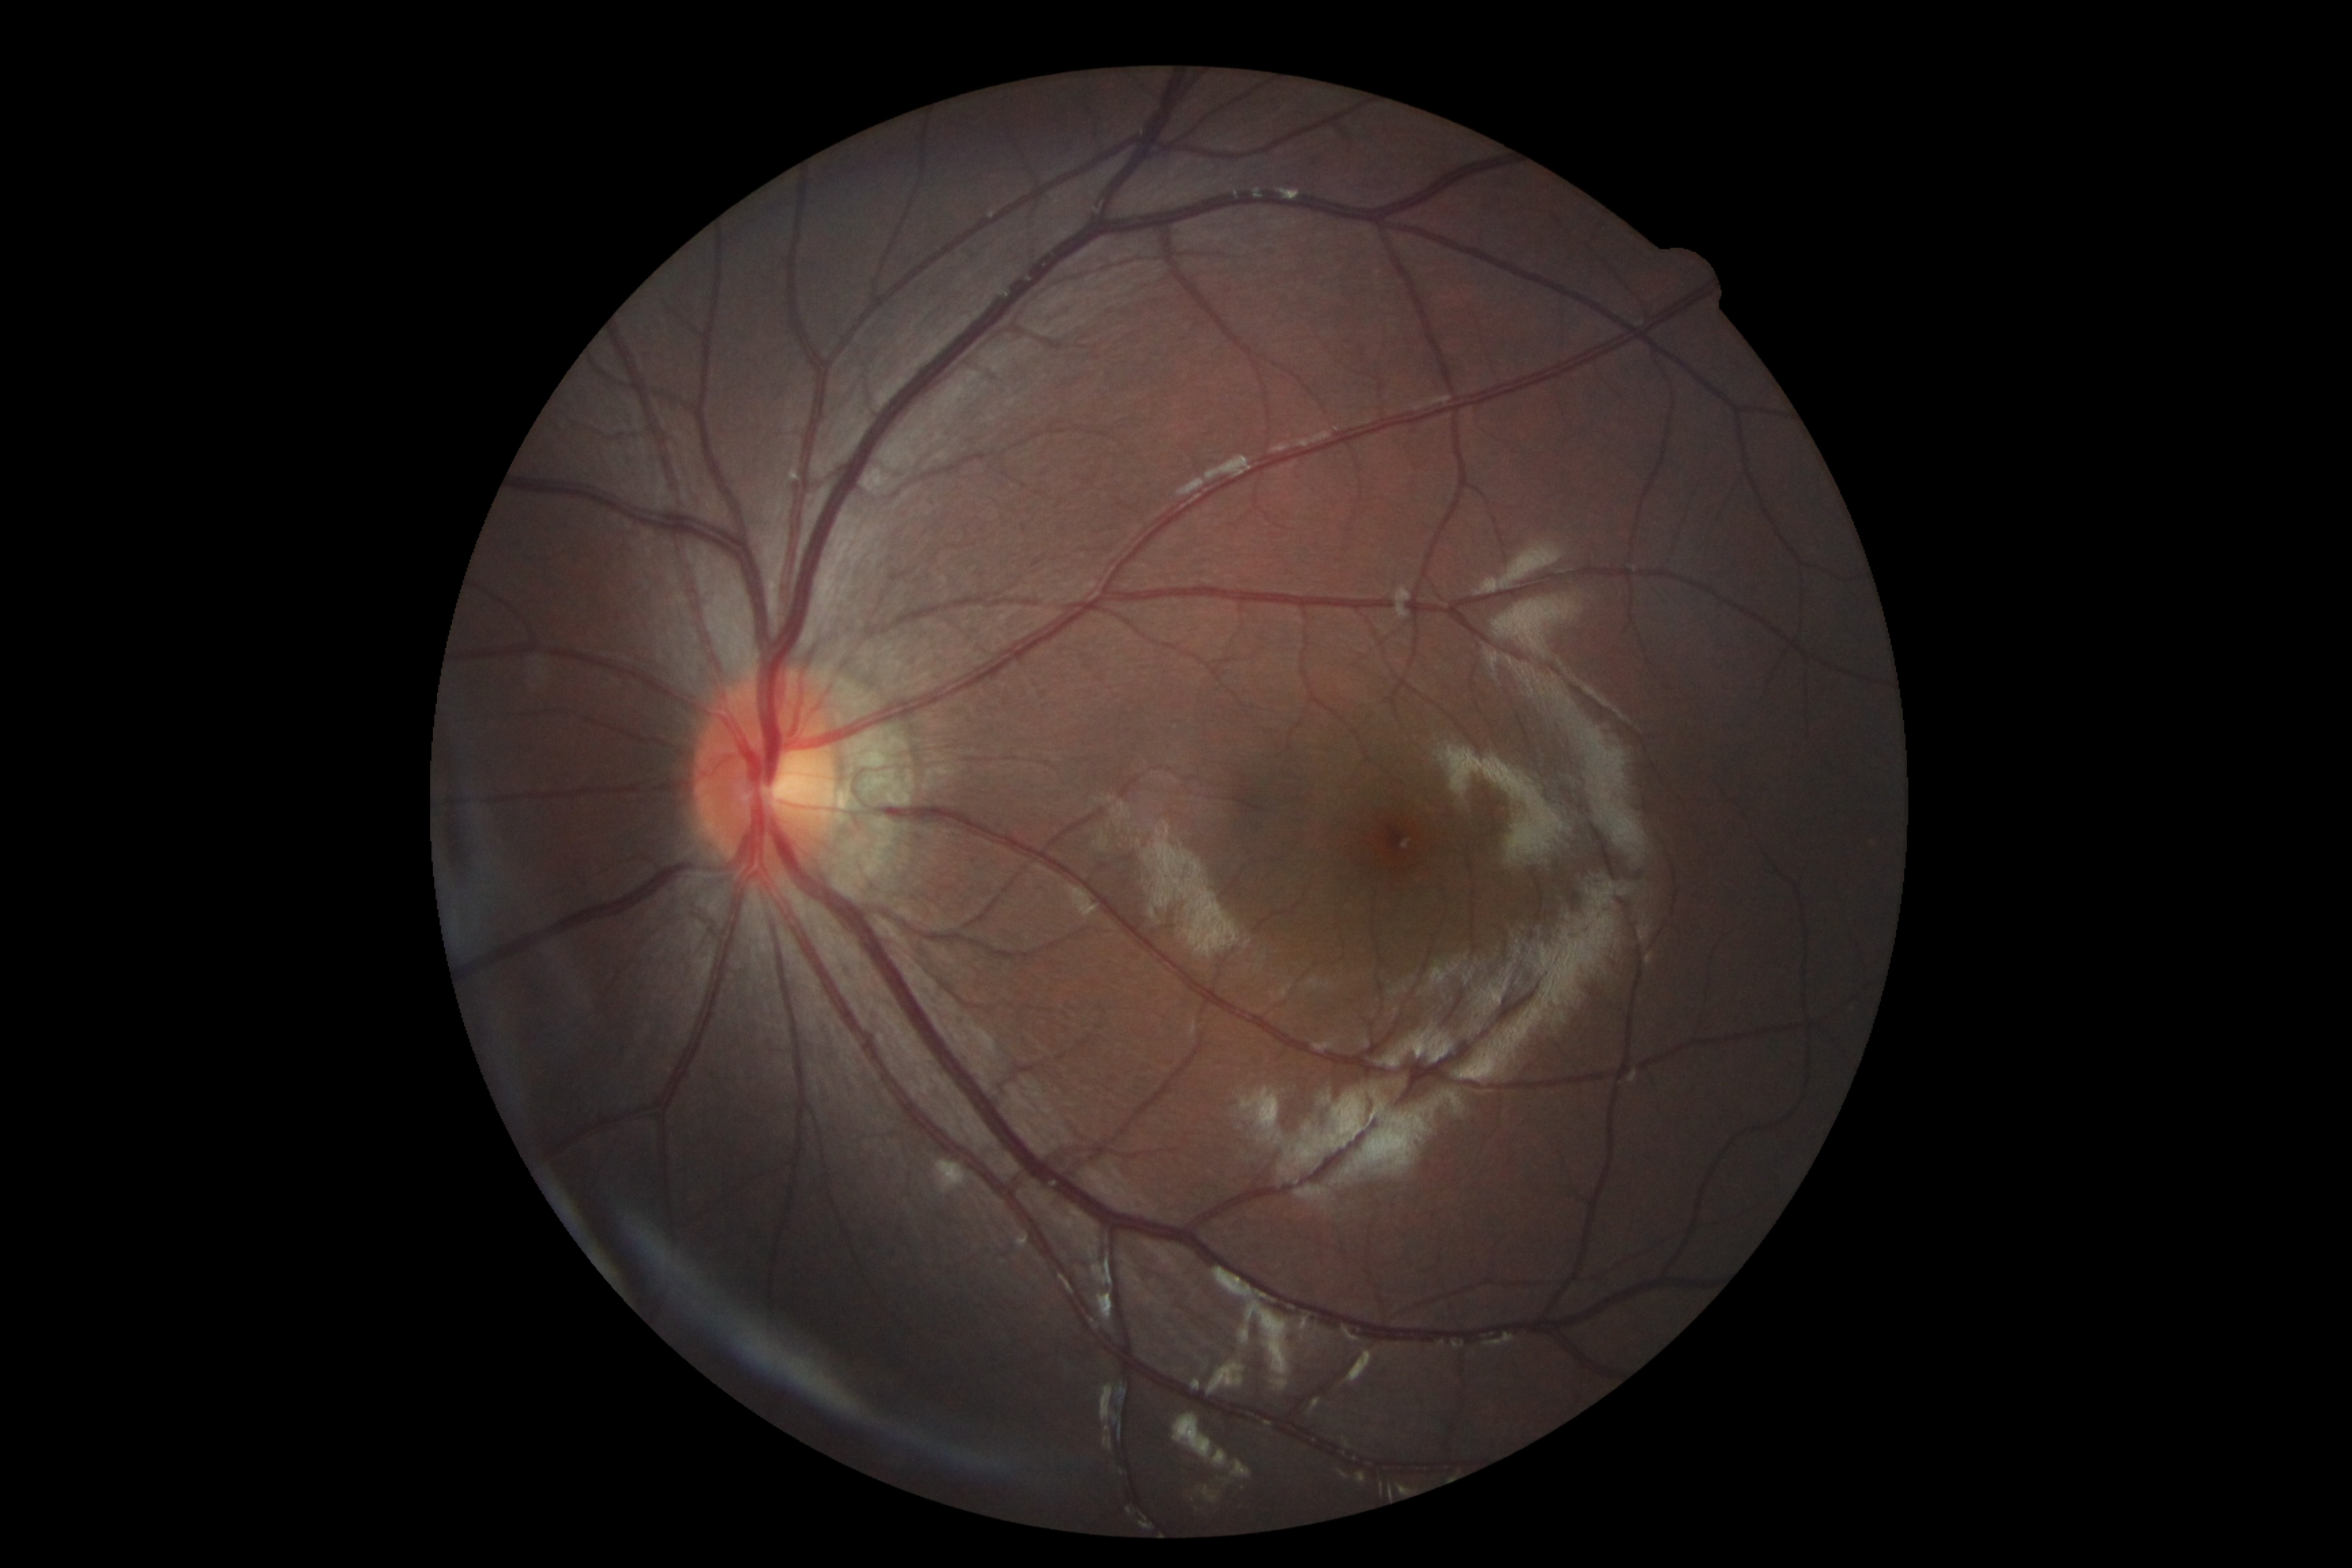 Annotations:
- diabetic retinopathy grade — 0